Captured with the Clarity RetCam 3 (130° field of view) · pediatric retinal photograph (wide-field) — 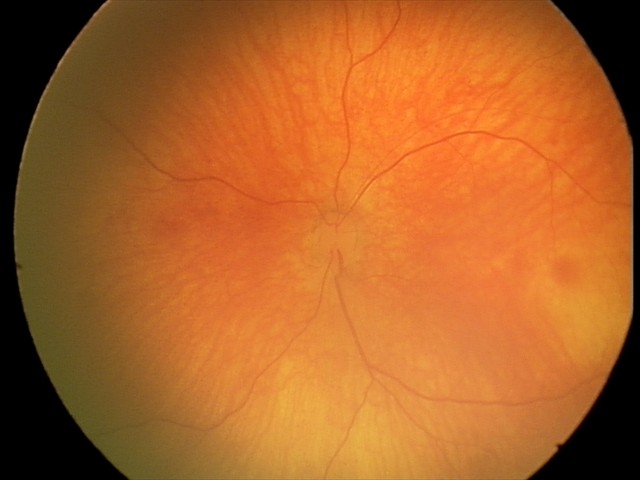

Screening diagnosis = physiological appearance